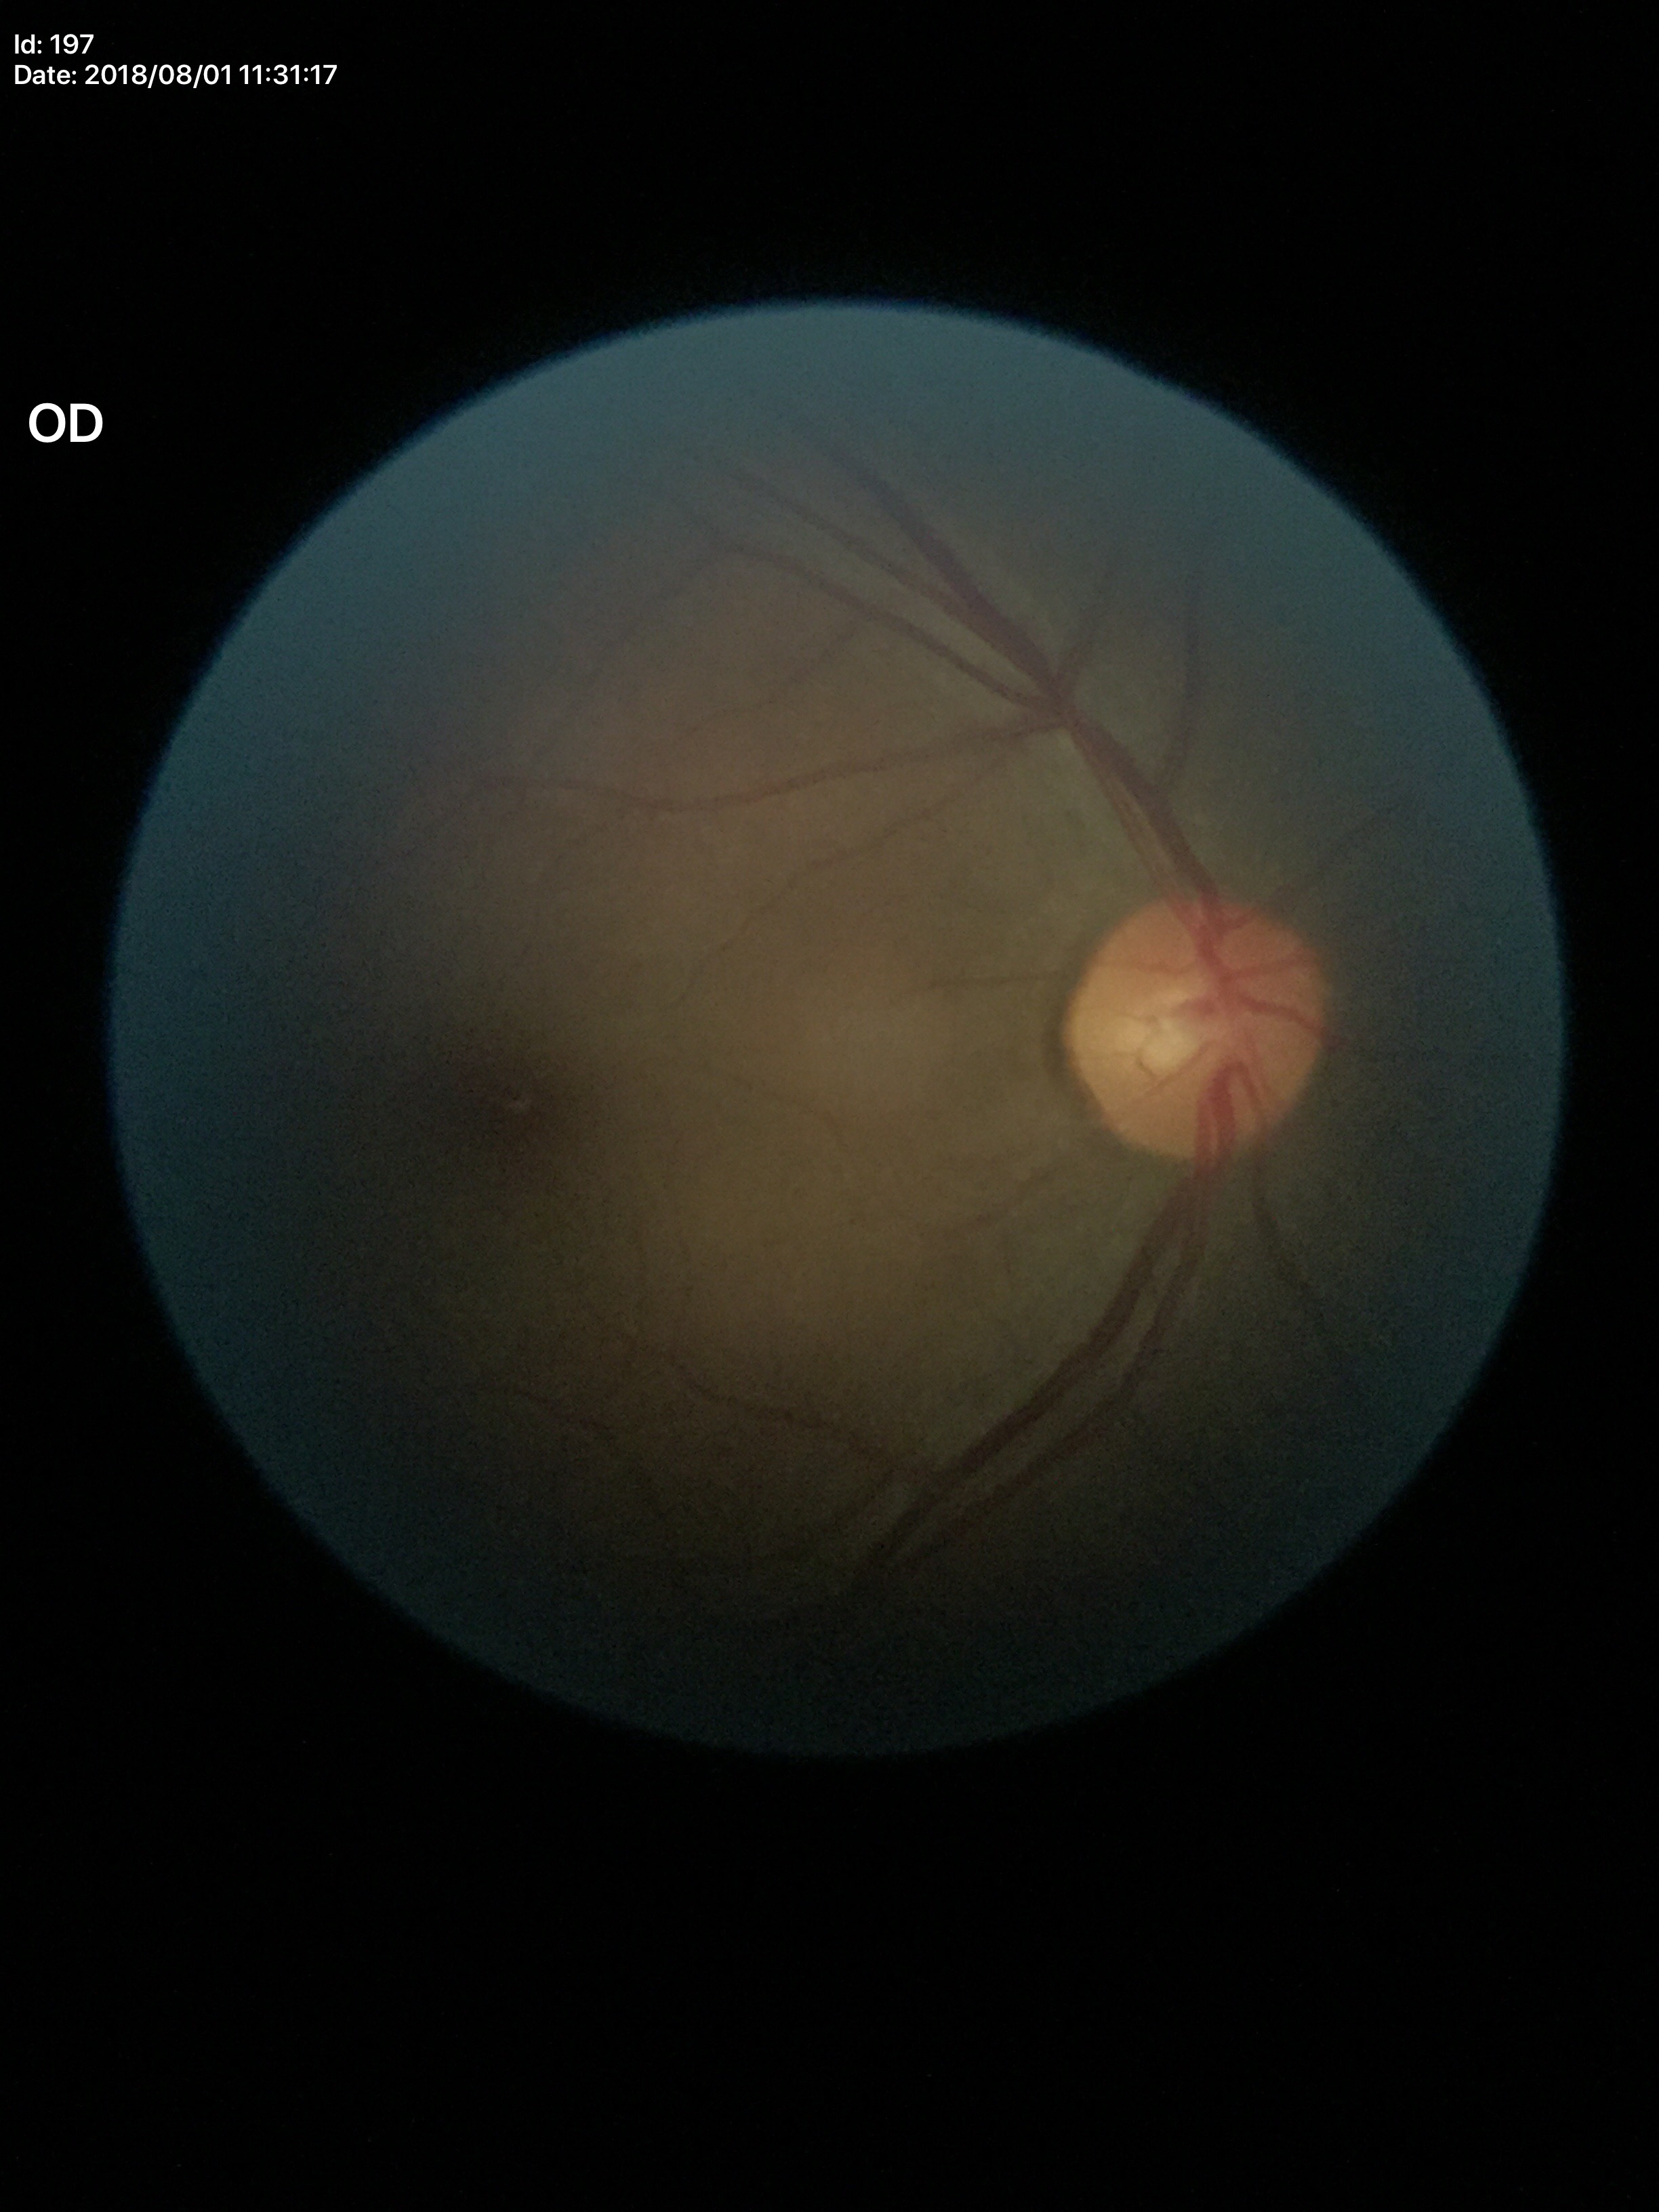

Q: What is the area cup-to-disc ratio?
A: 0.23
Q: Is there glaucoma suspicion?
A: no suspicious findings
Q: What is the vertical cup-to-disc ratio?
A: 0.46
Q: What is the HCDR?
A: 0.51